Wide-field fundus photograph of an infant; 100° field of view (Phoenix ICON)
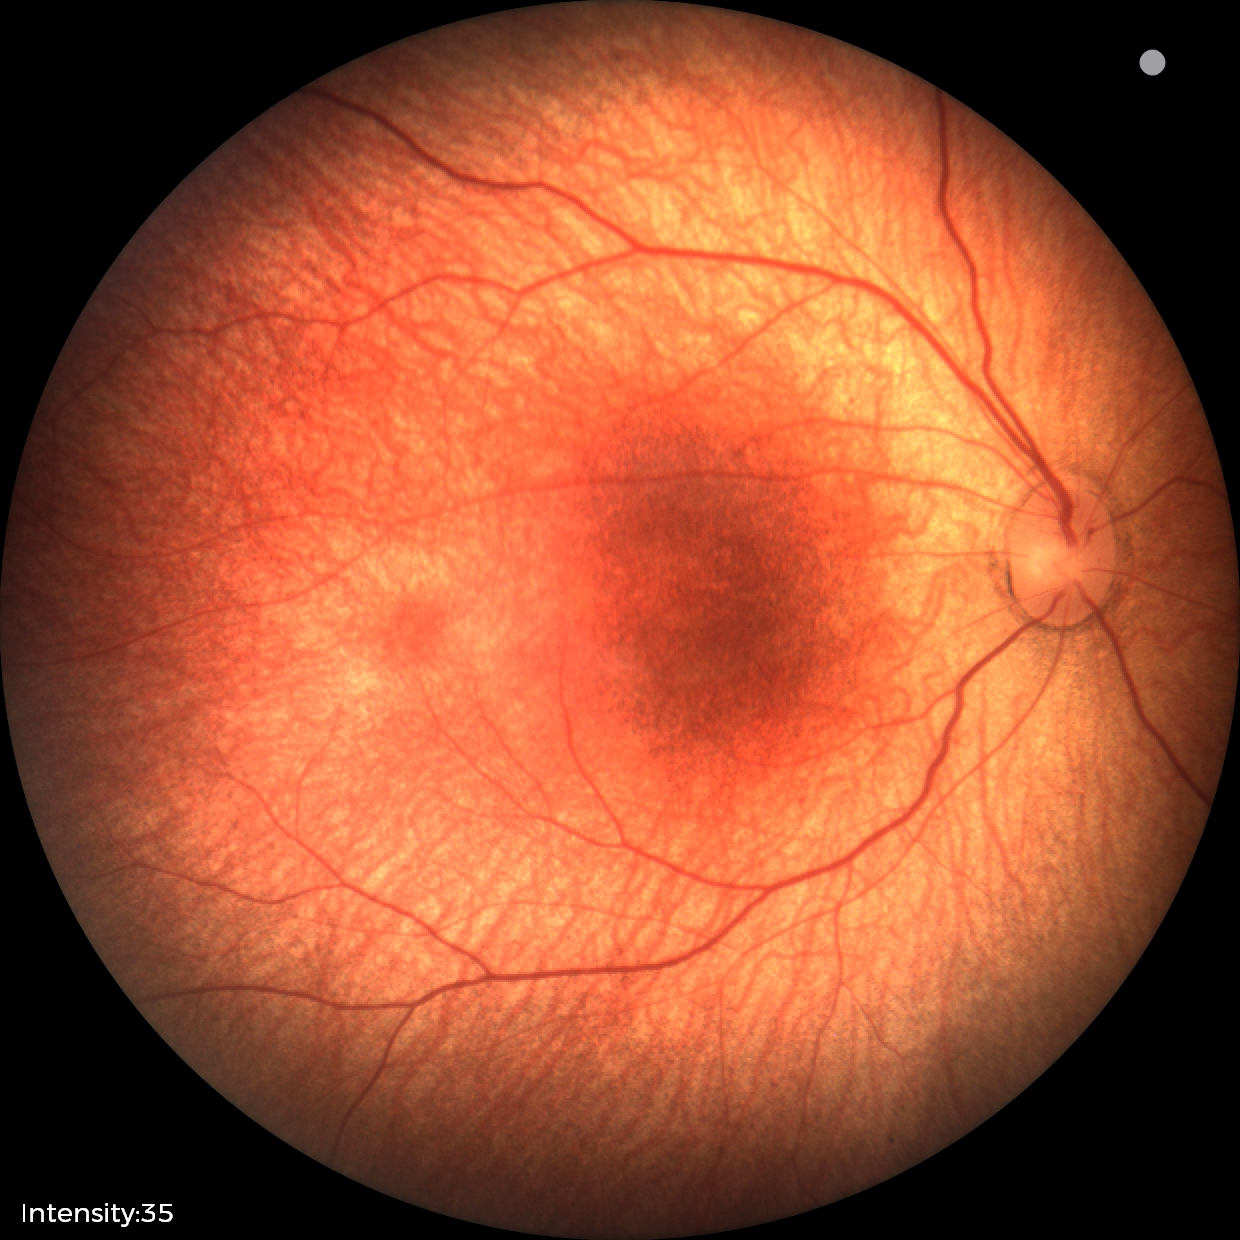

Diagnosis = normal retinal appearance.